Fundus photo, acquired with a NIDEK AFC-230, nonmydriatic fundus photograph, 45° field of view, 848x848: 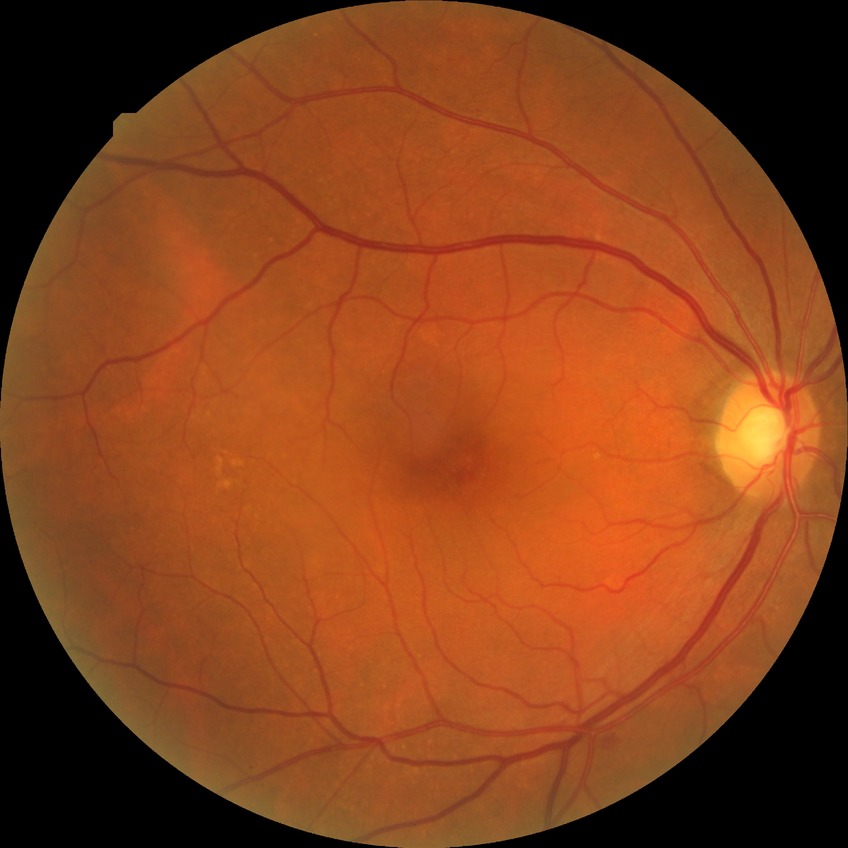
Diabetic retinopathy (DR) is NDR (no diabetic retinopathy).